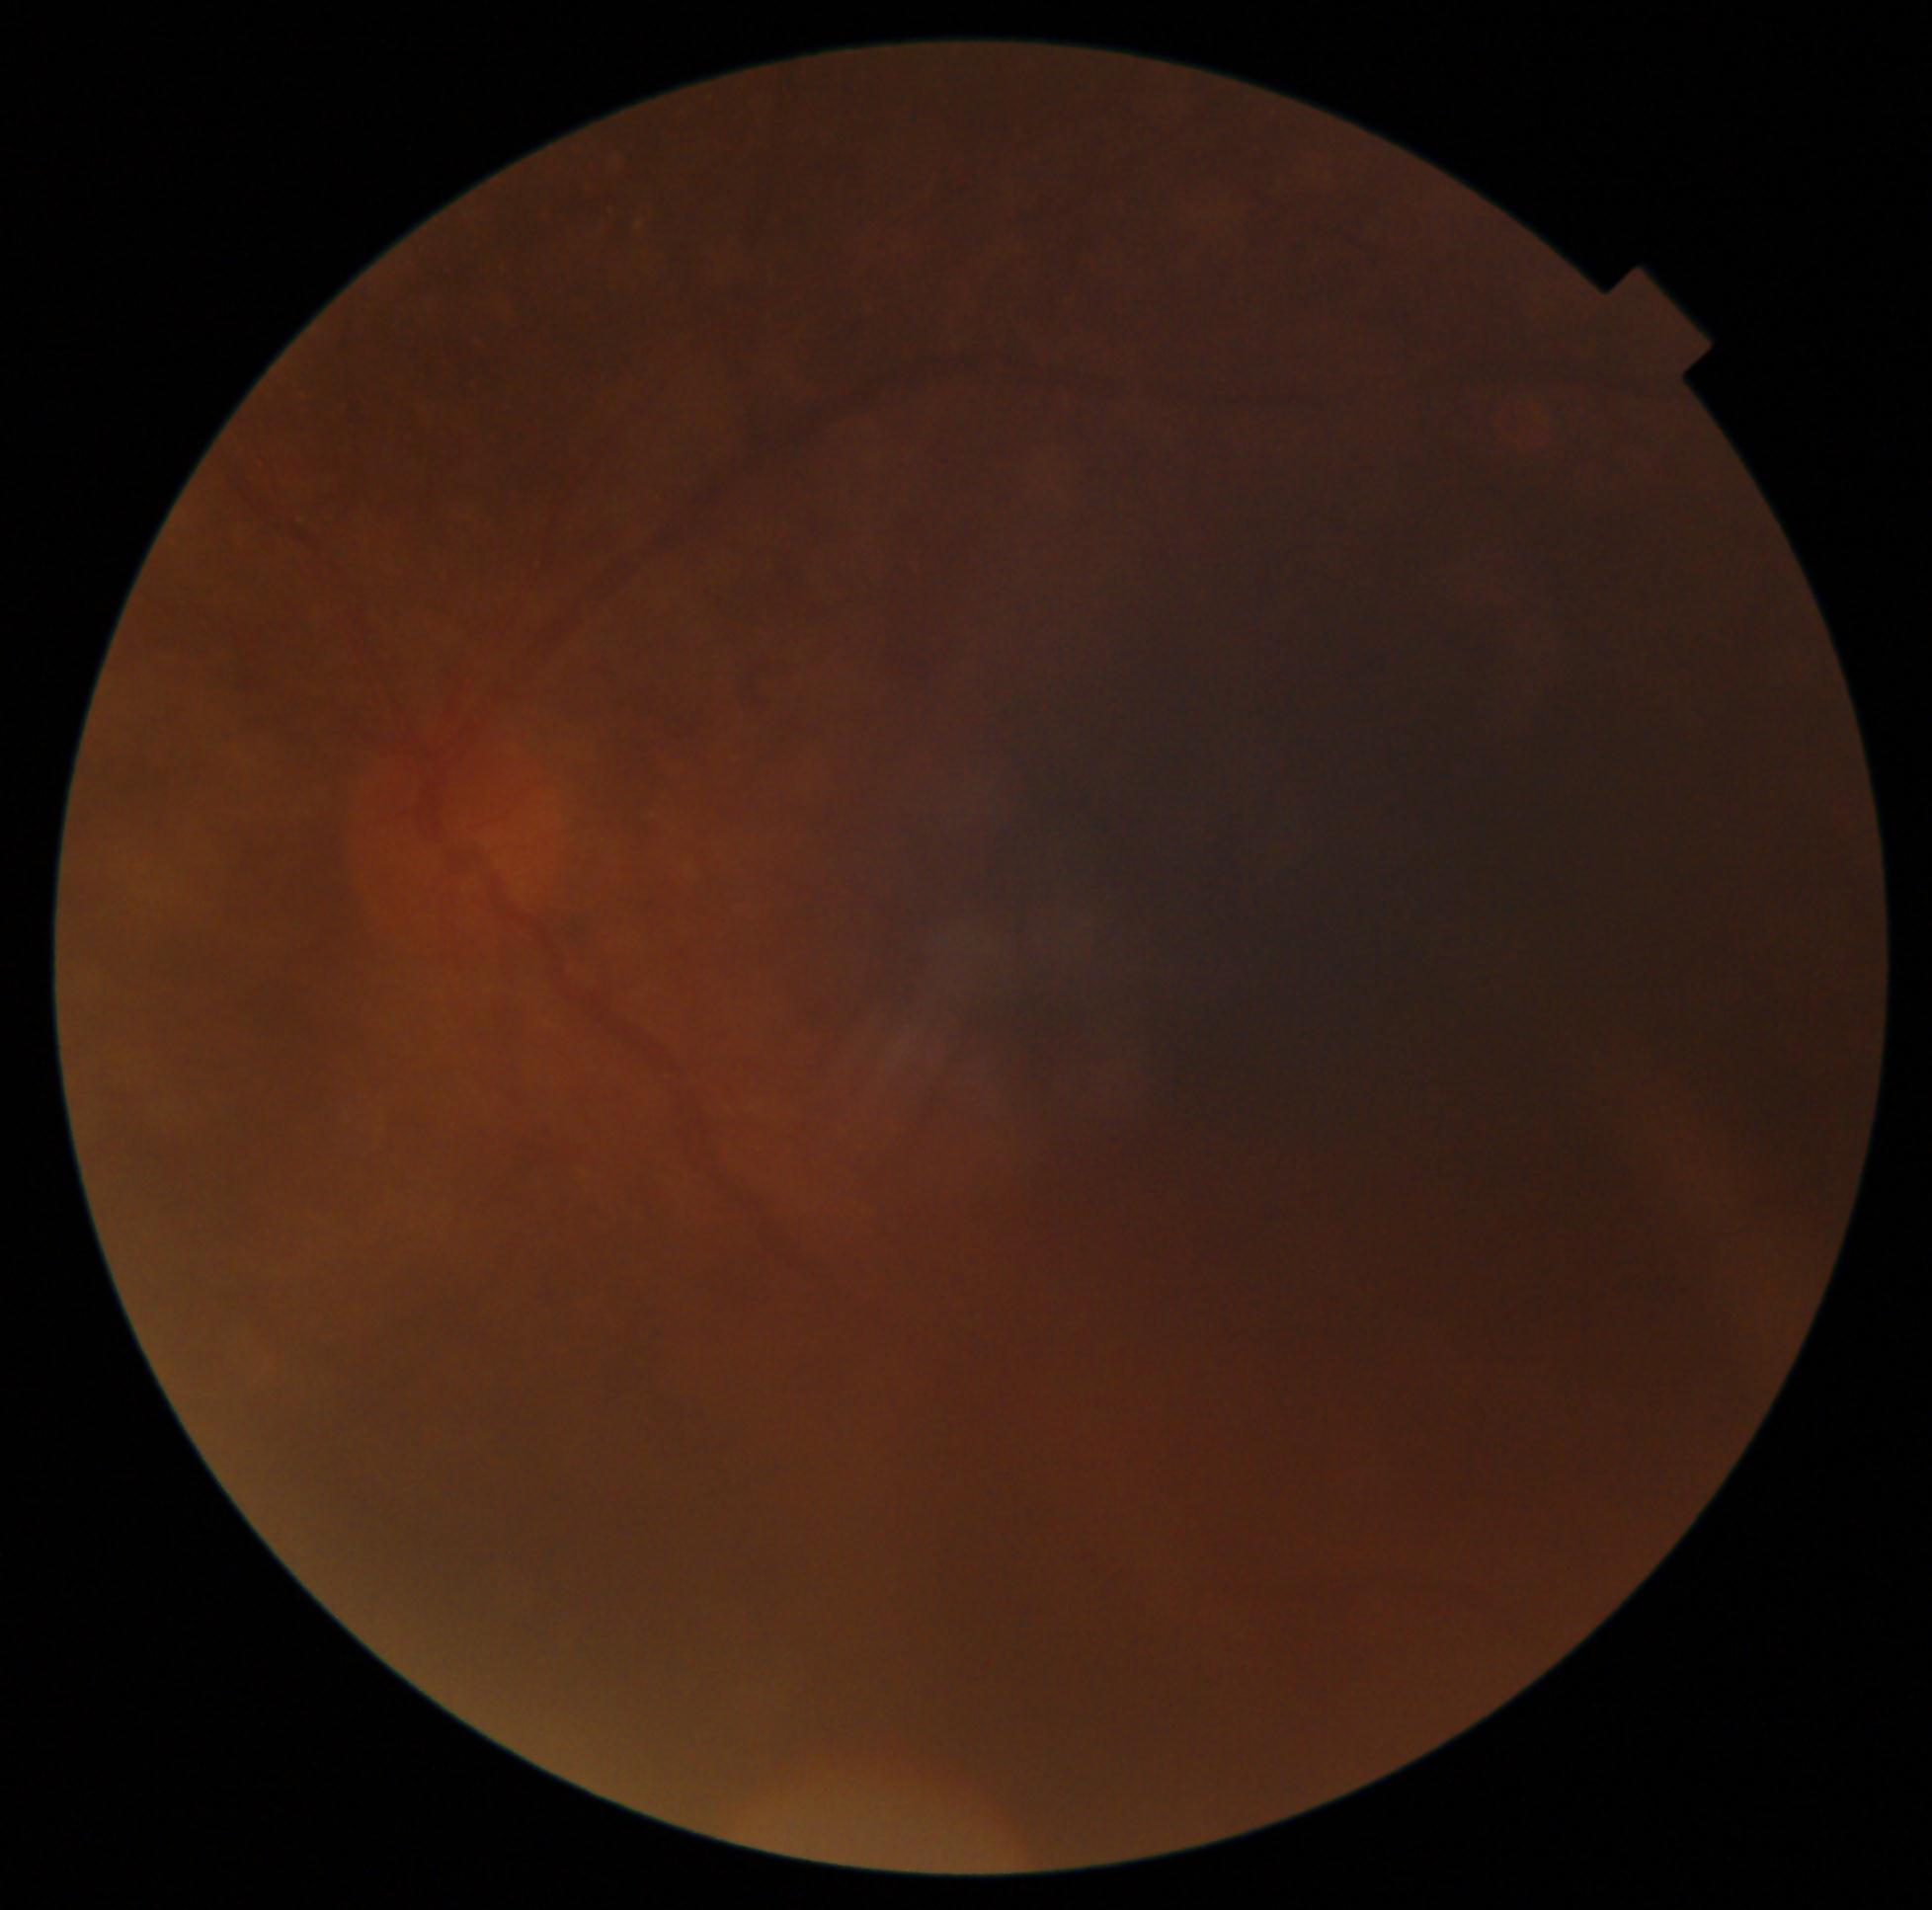

• diabetic retinopathy grade — ungradable due to poor image quality